Image size 1240x1240 · 100° field of view (Phoenix ICON) · wide-field fundus photograph of an infant
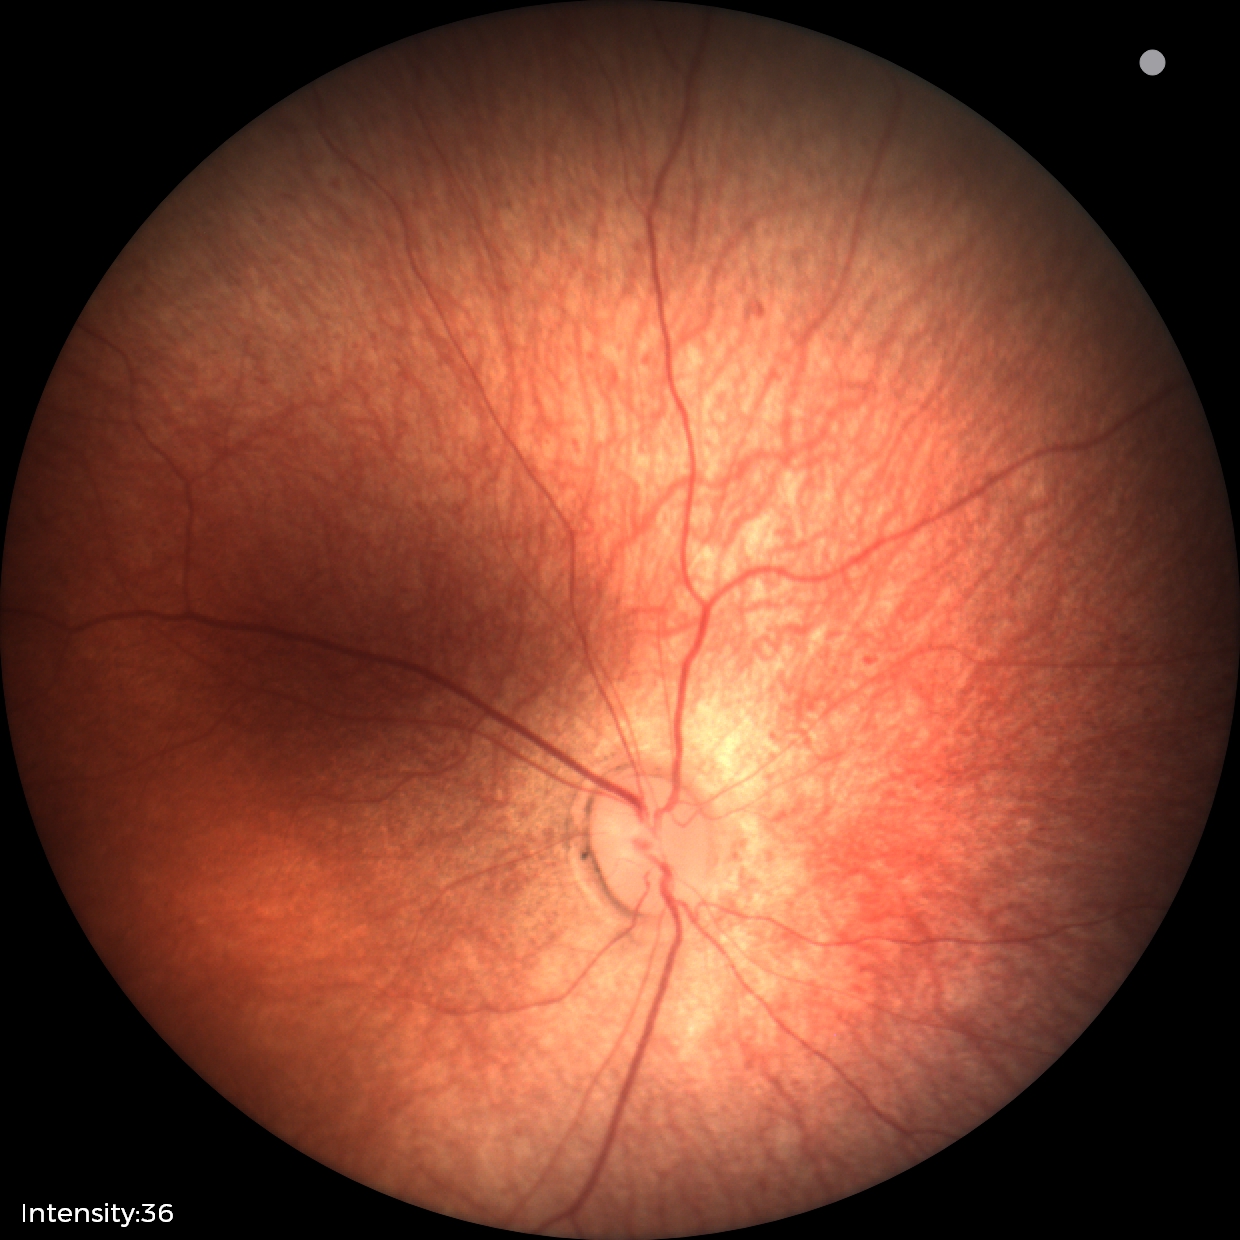 Q: What is the screening diagnosis?
A: normal retinal appearance